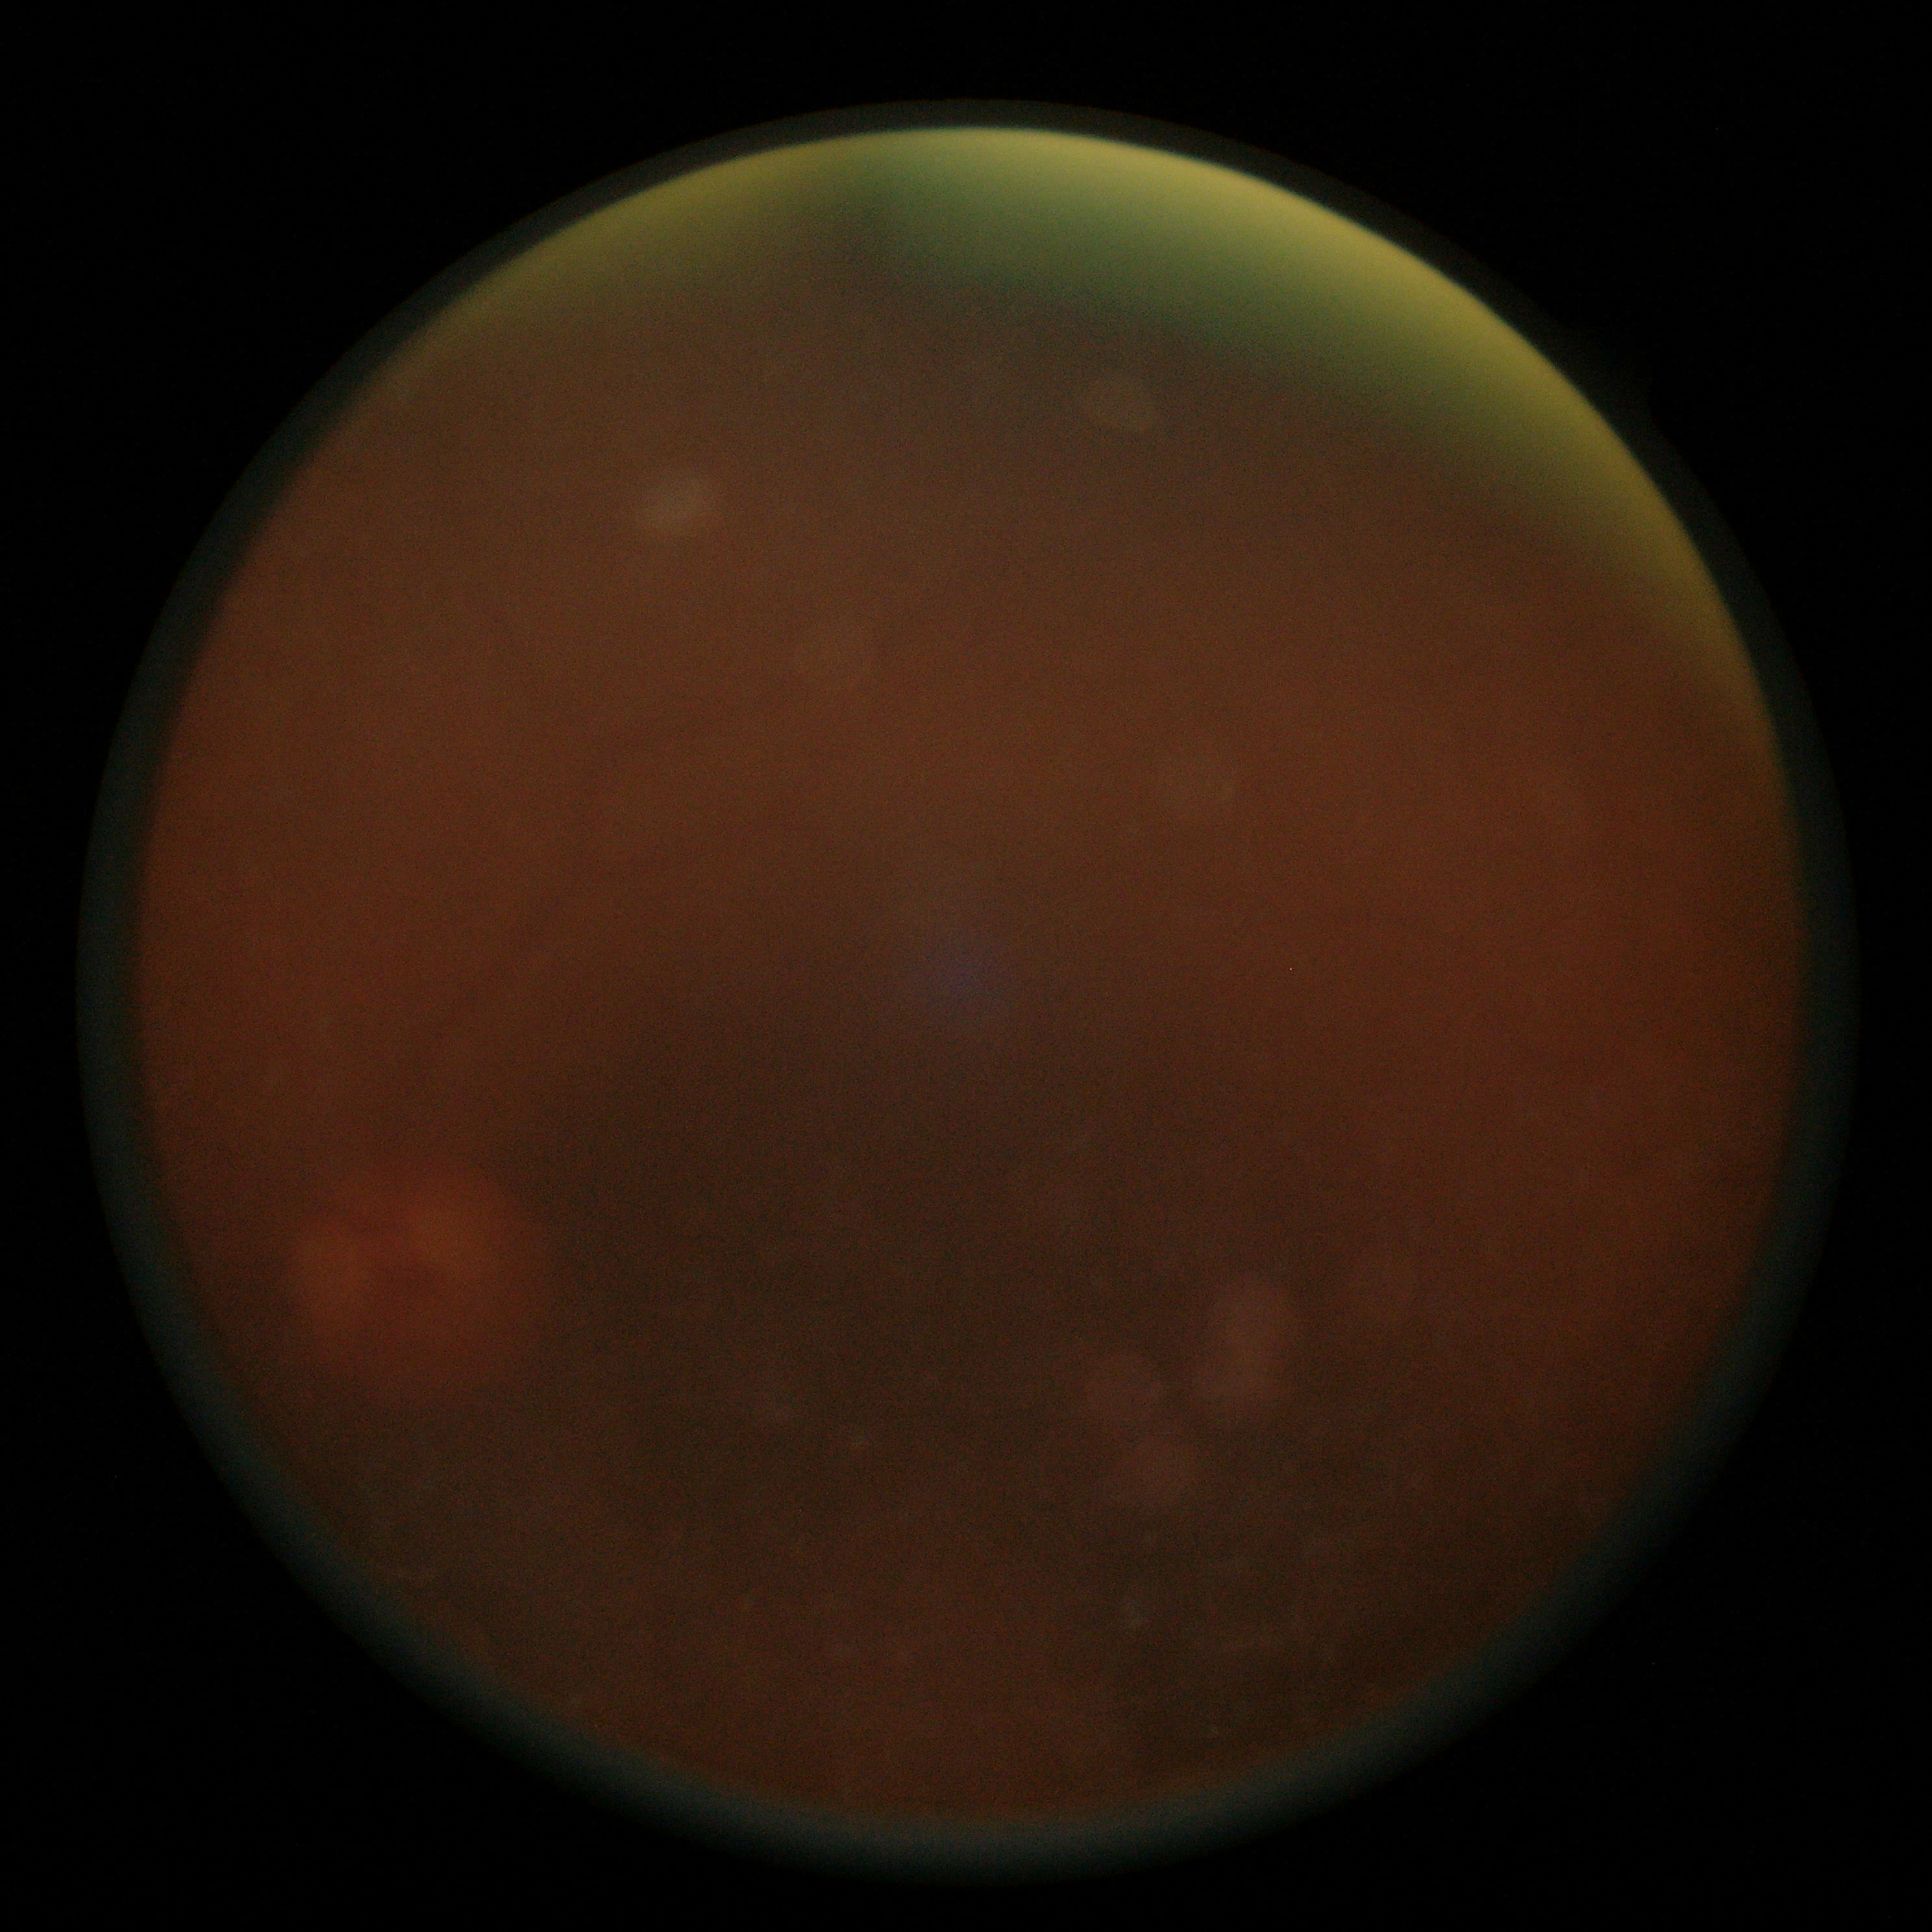
Ungradable image — DR severity cannot be determined.
Retinopathy grade: ungradable due to poor image quality.